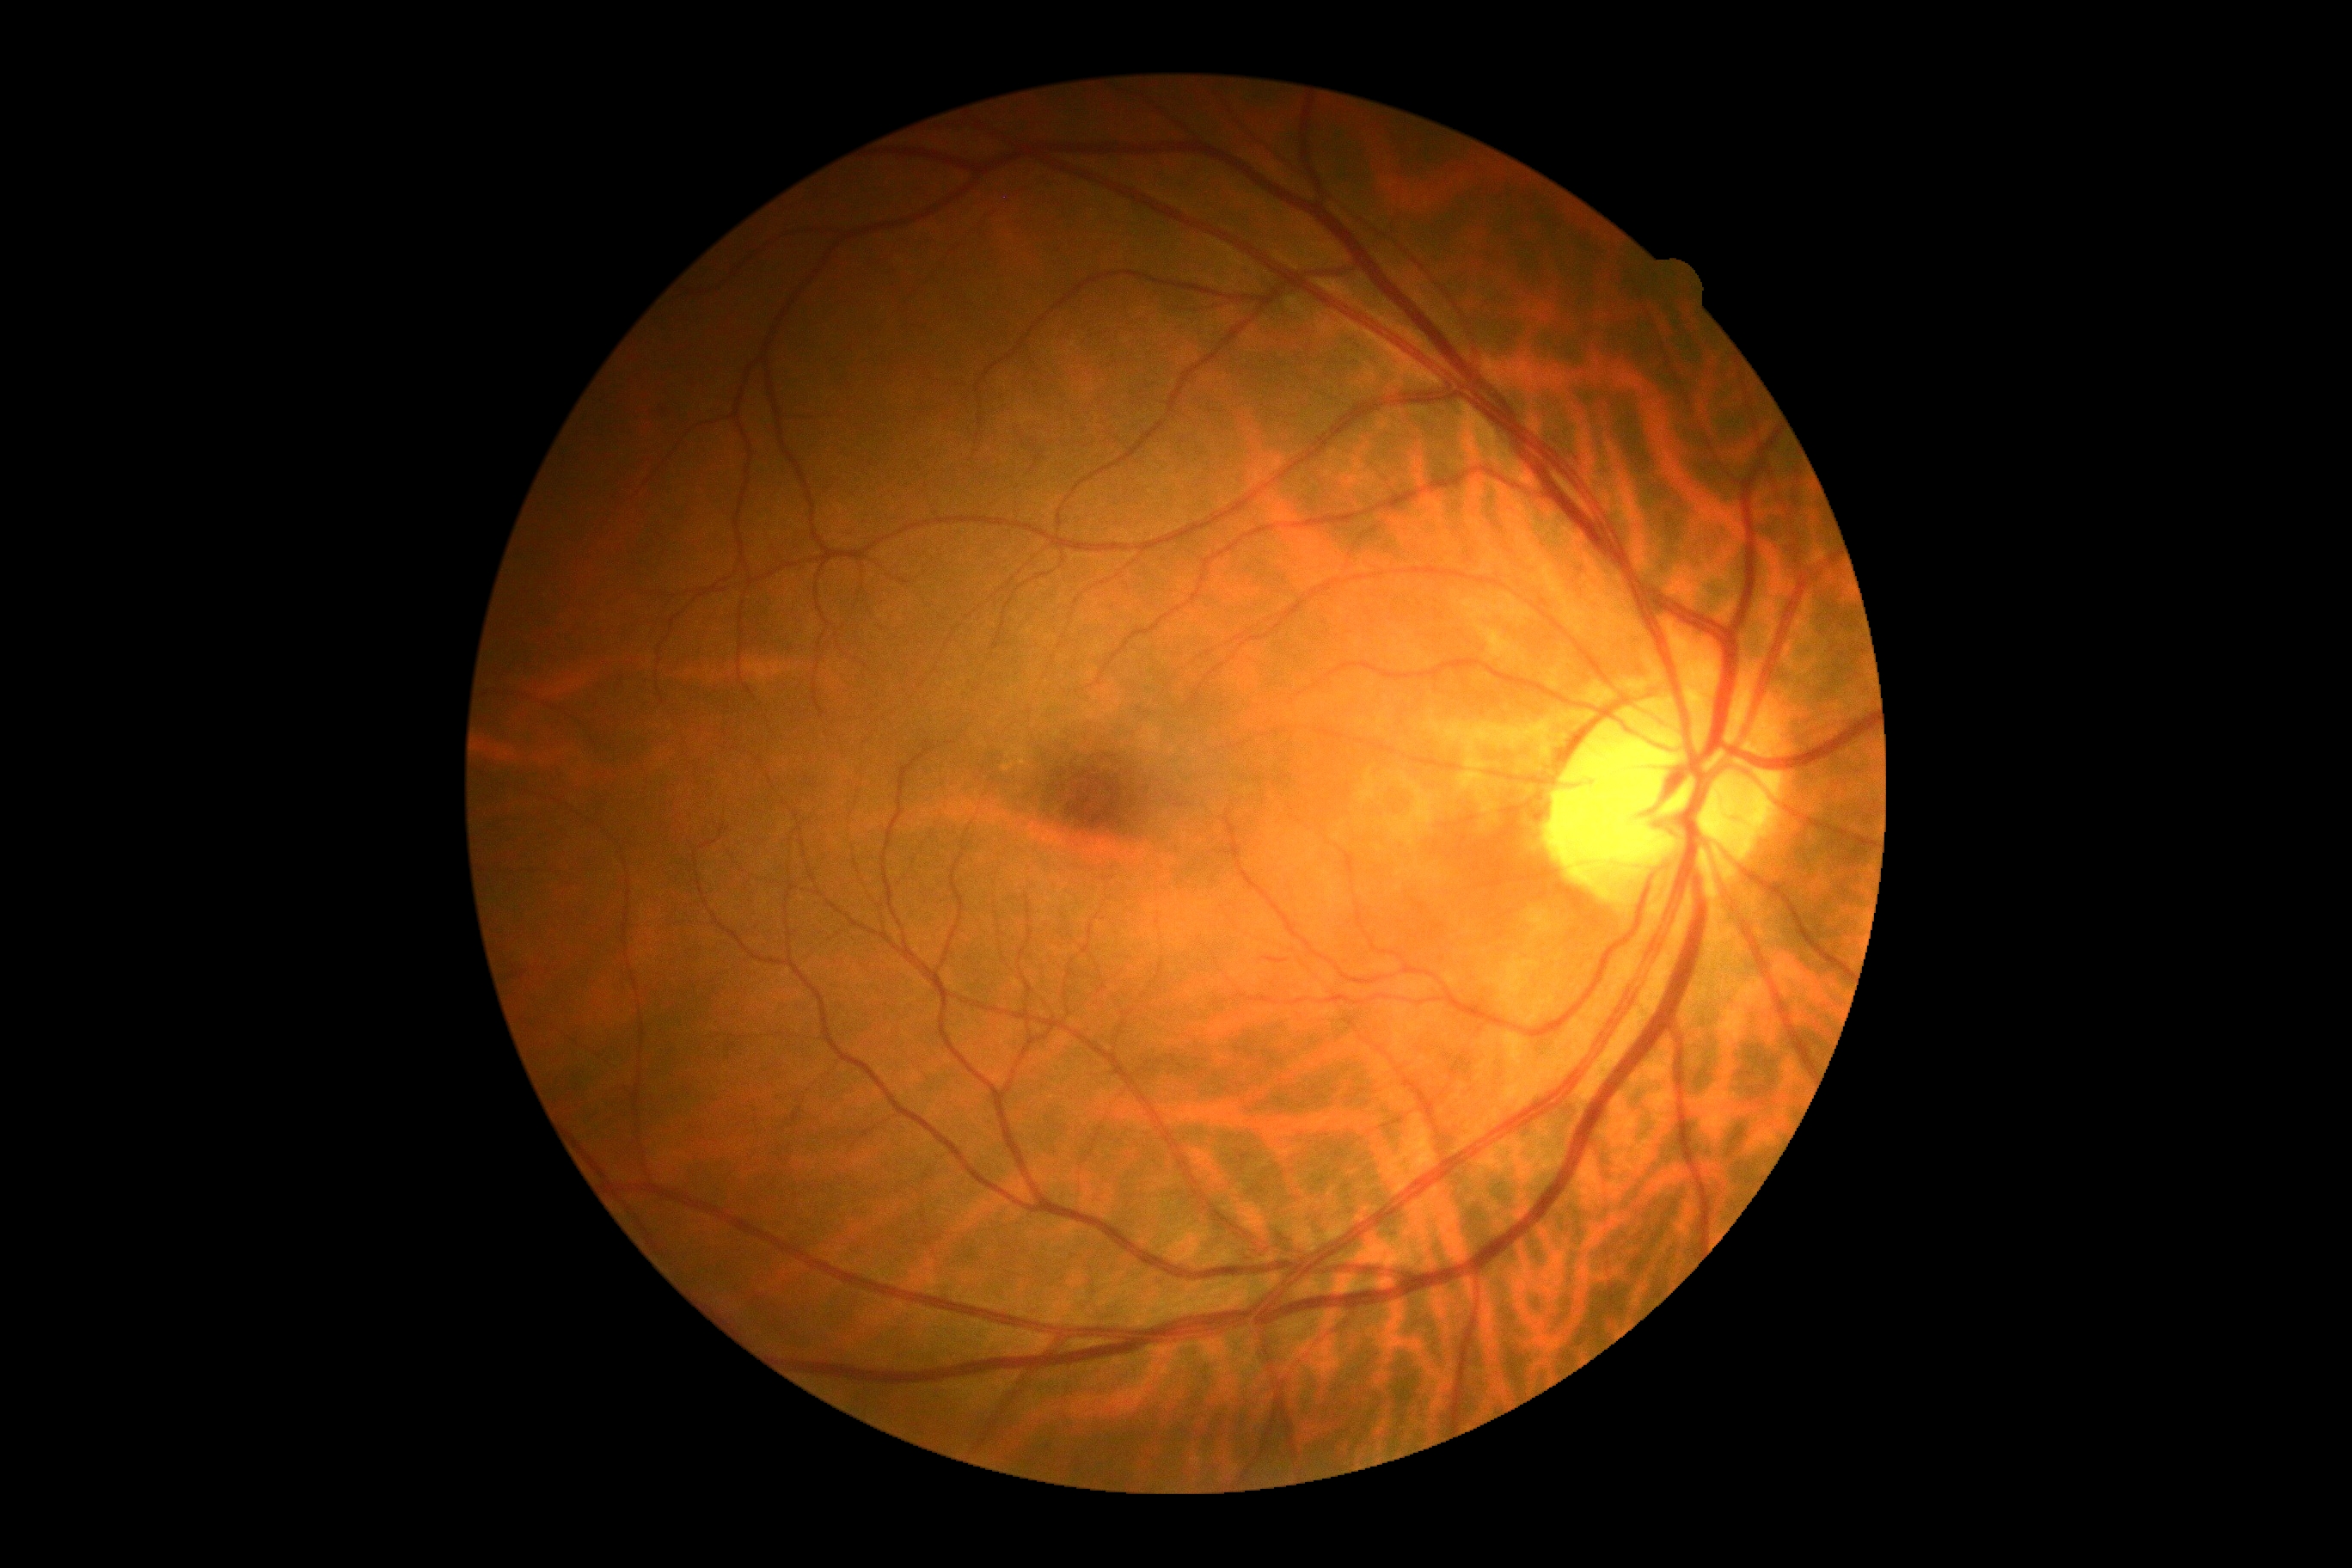 Diabetic retinopathy (DR): 0/4.